45° field of view
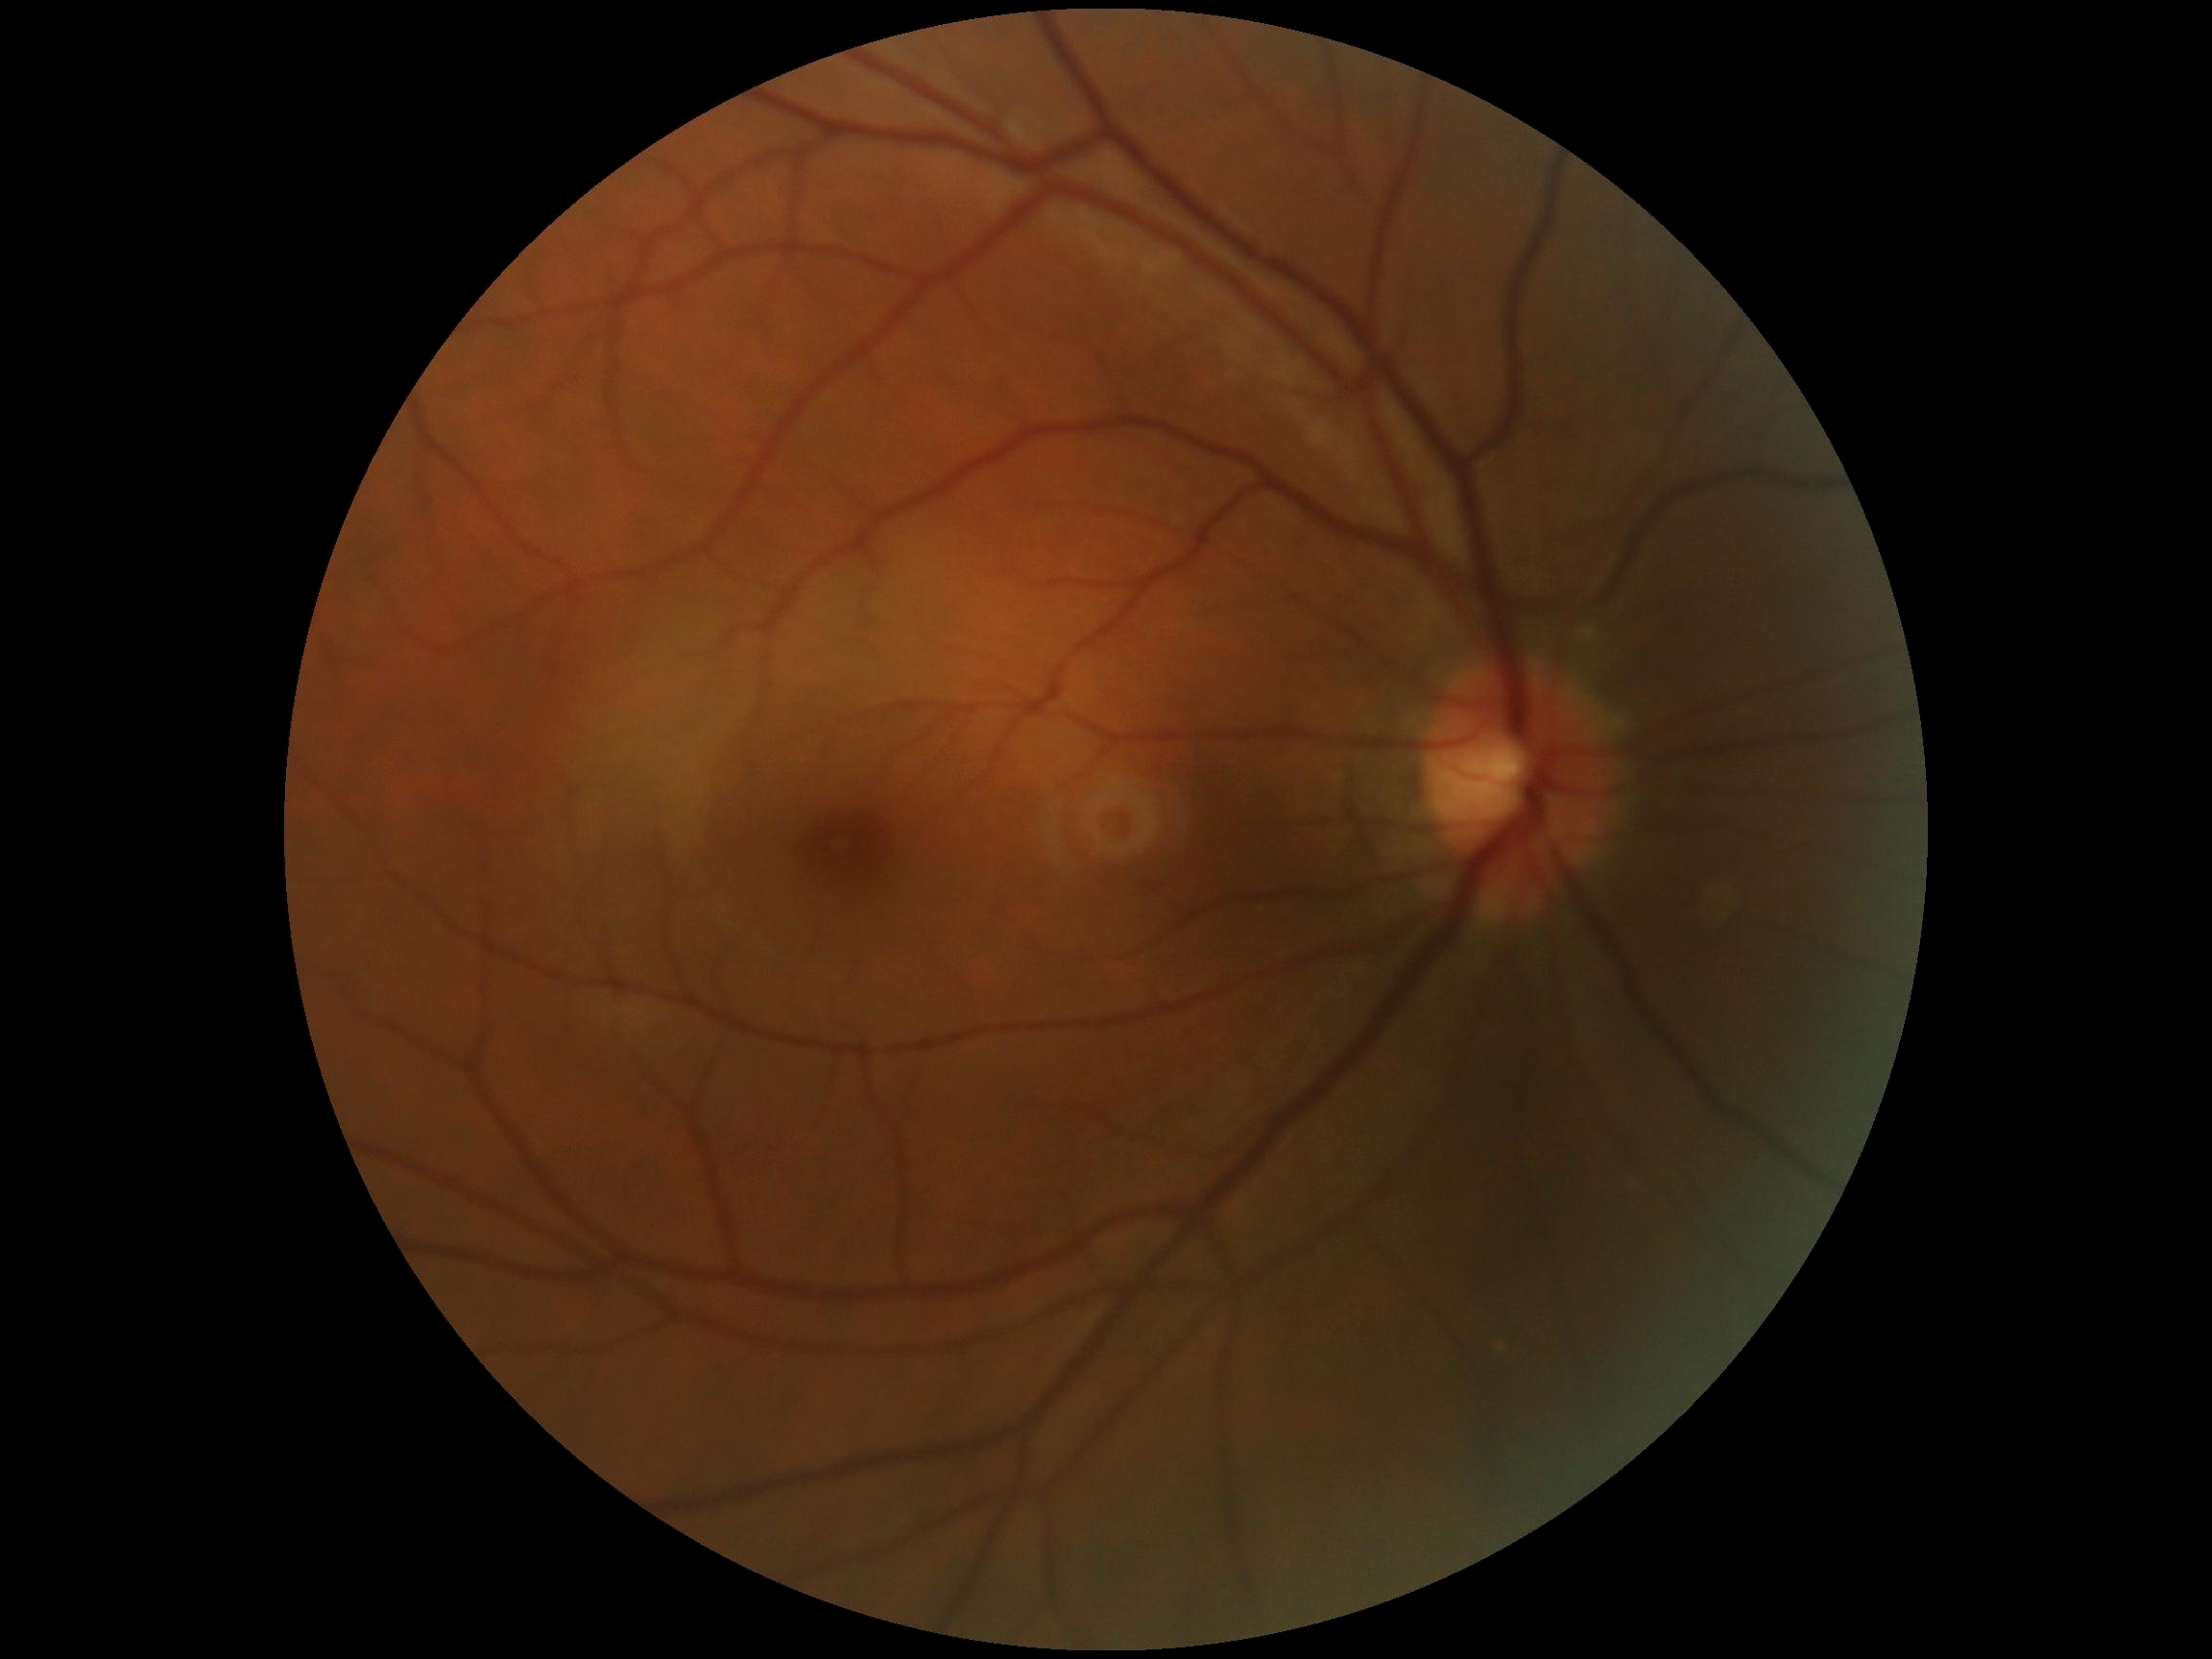 DR severity is grade 0 (no apparent retinopathy).